Ultra-widefield fundus photograph · 200° field of view.
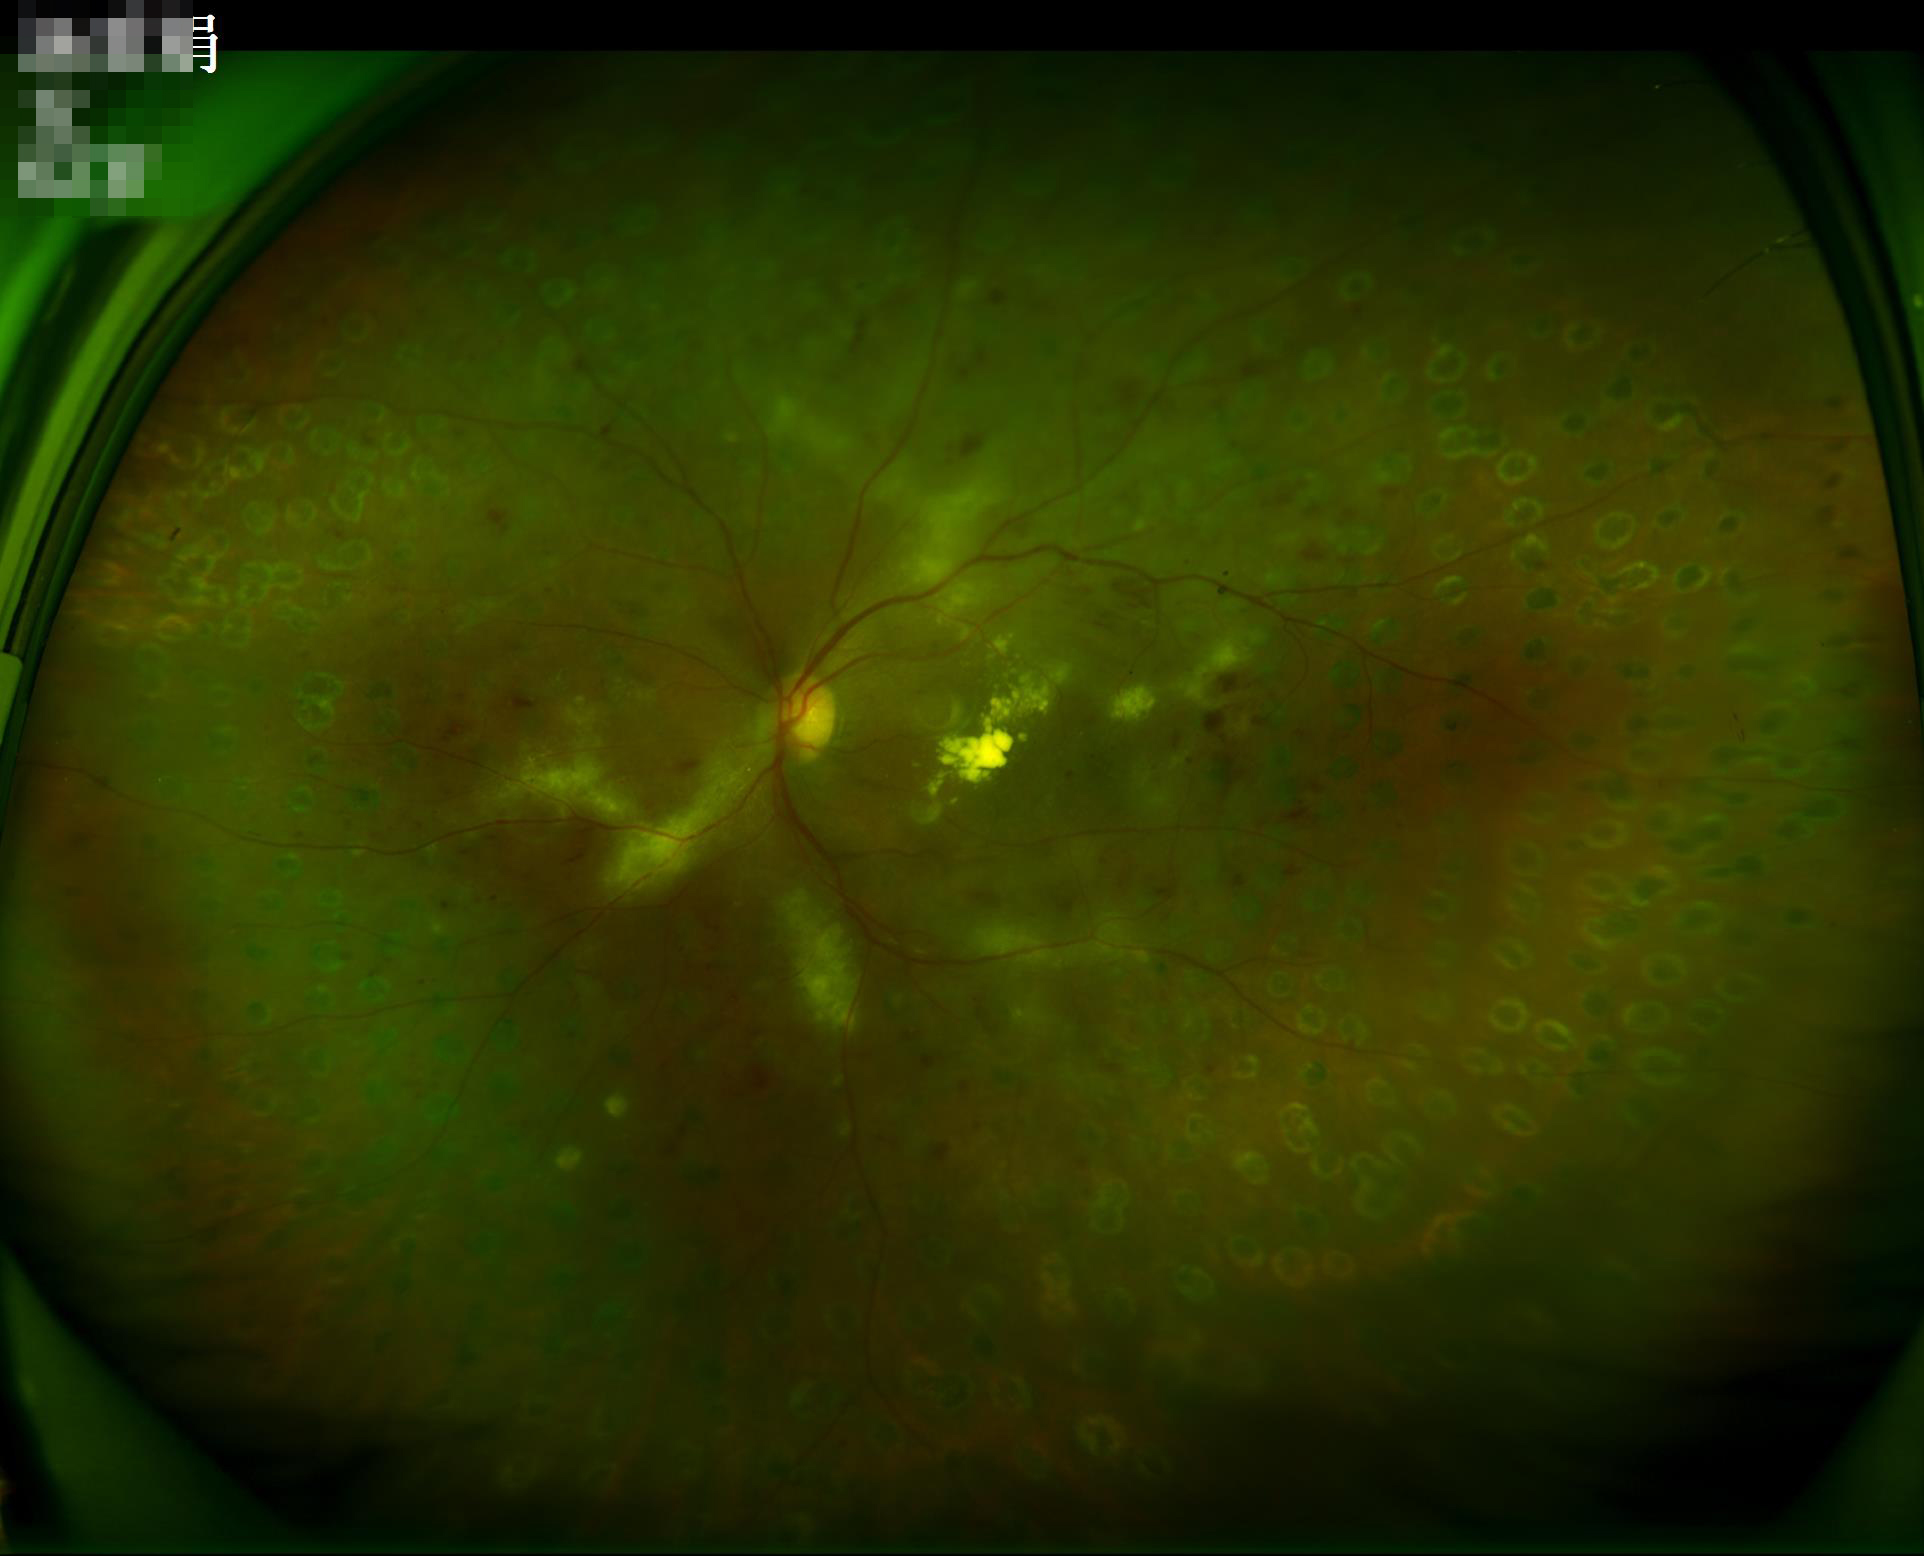

Overall quality is good and the image is gradable. Even illumination with no color cast. Contrast is good.